Graded on the modified Davis scale. No pharmacologic dilation
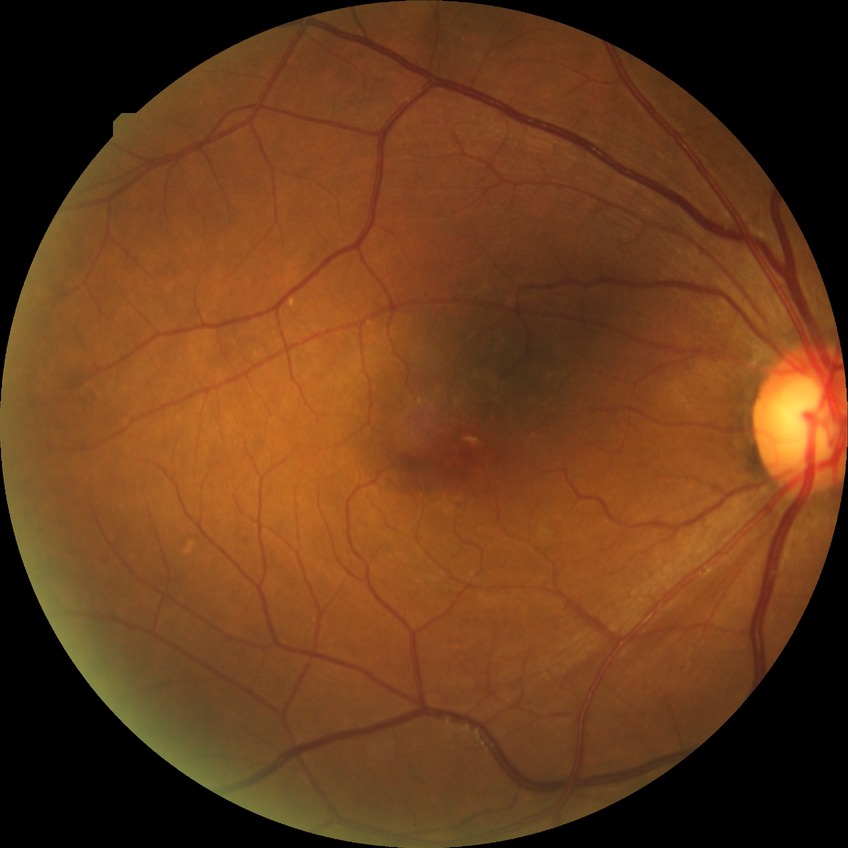

Diabetic retinopathy (DR): no diabetic retinopathy (NDR).